Optic disc-centered crop; acquired with a Nidek AFC-330: 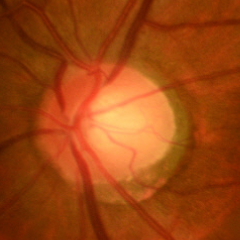 Glaucomatous changes are present. Diagnosis = early glaucomatous optic neuropathy.